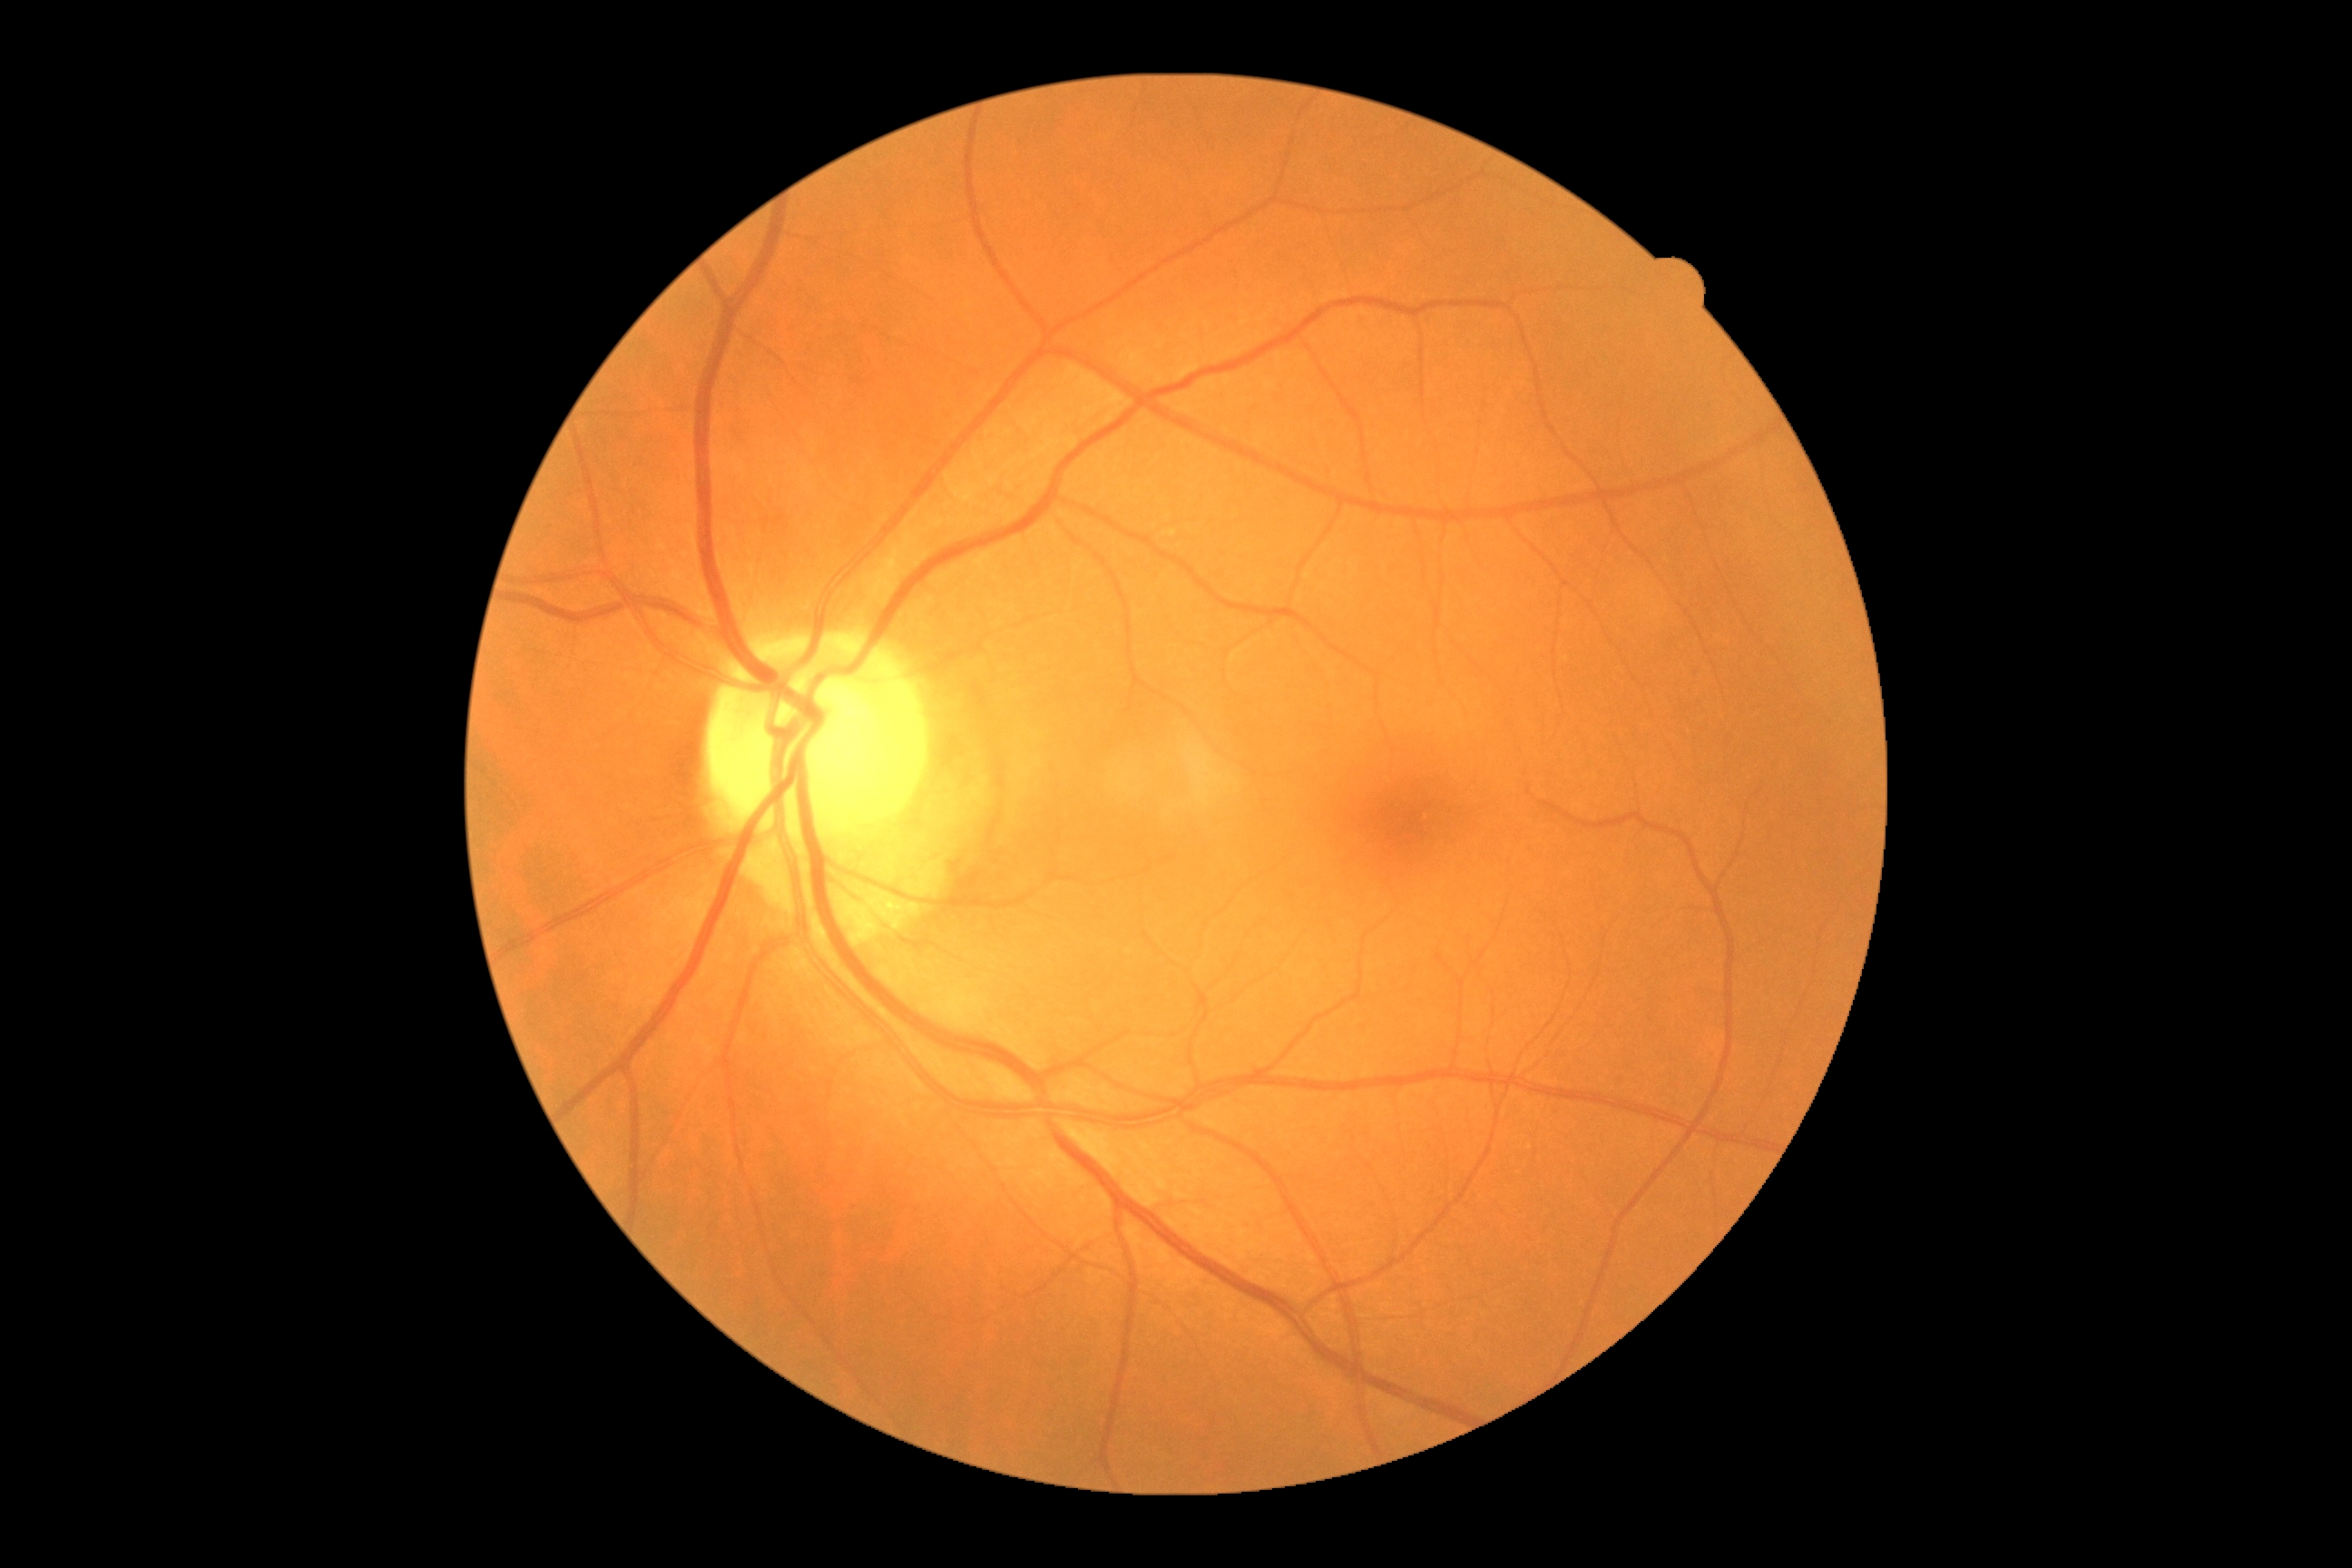
No DR findings. DR severity: grade 0 (no apparent retinopathy).